Davis DR grading.
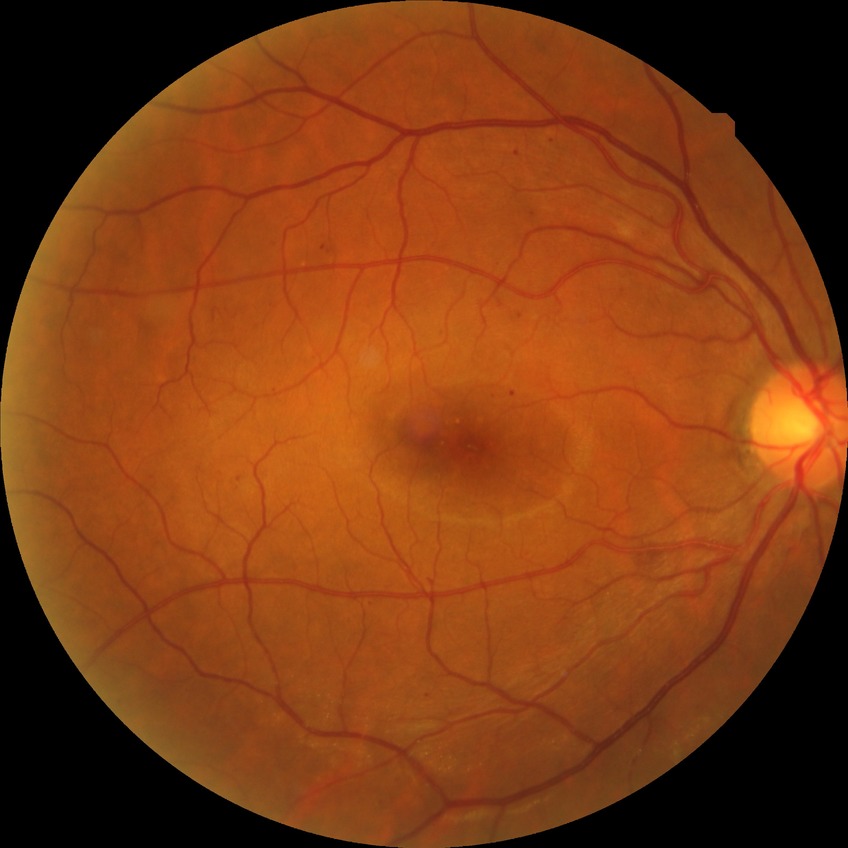 Diabetic retinopathy (DR): simple diabetic retinopathy (SDR).